Fundus photo; 2089x1764px: 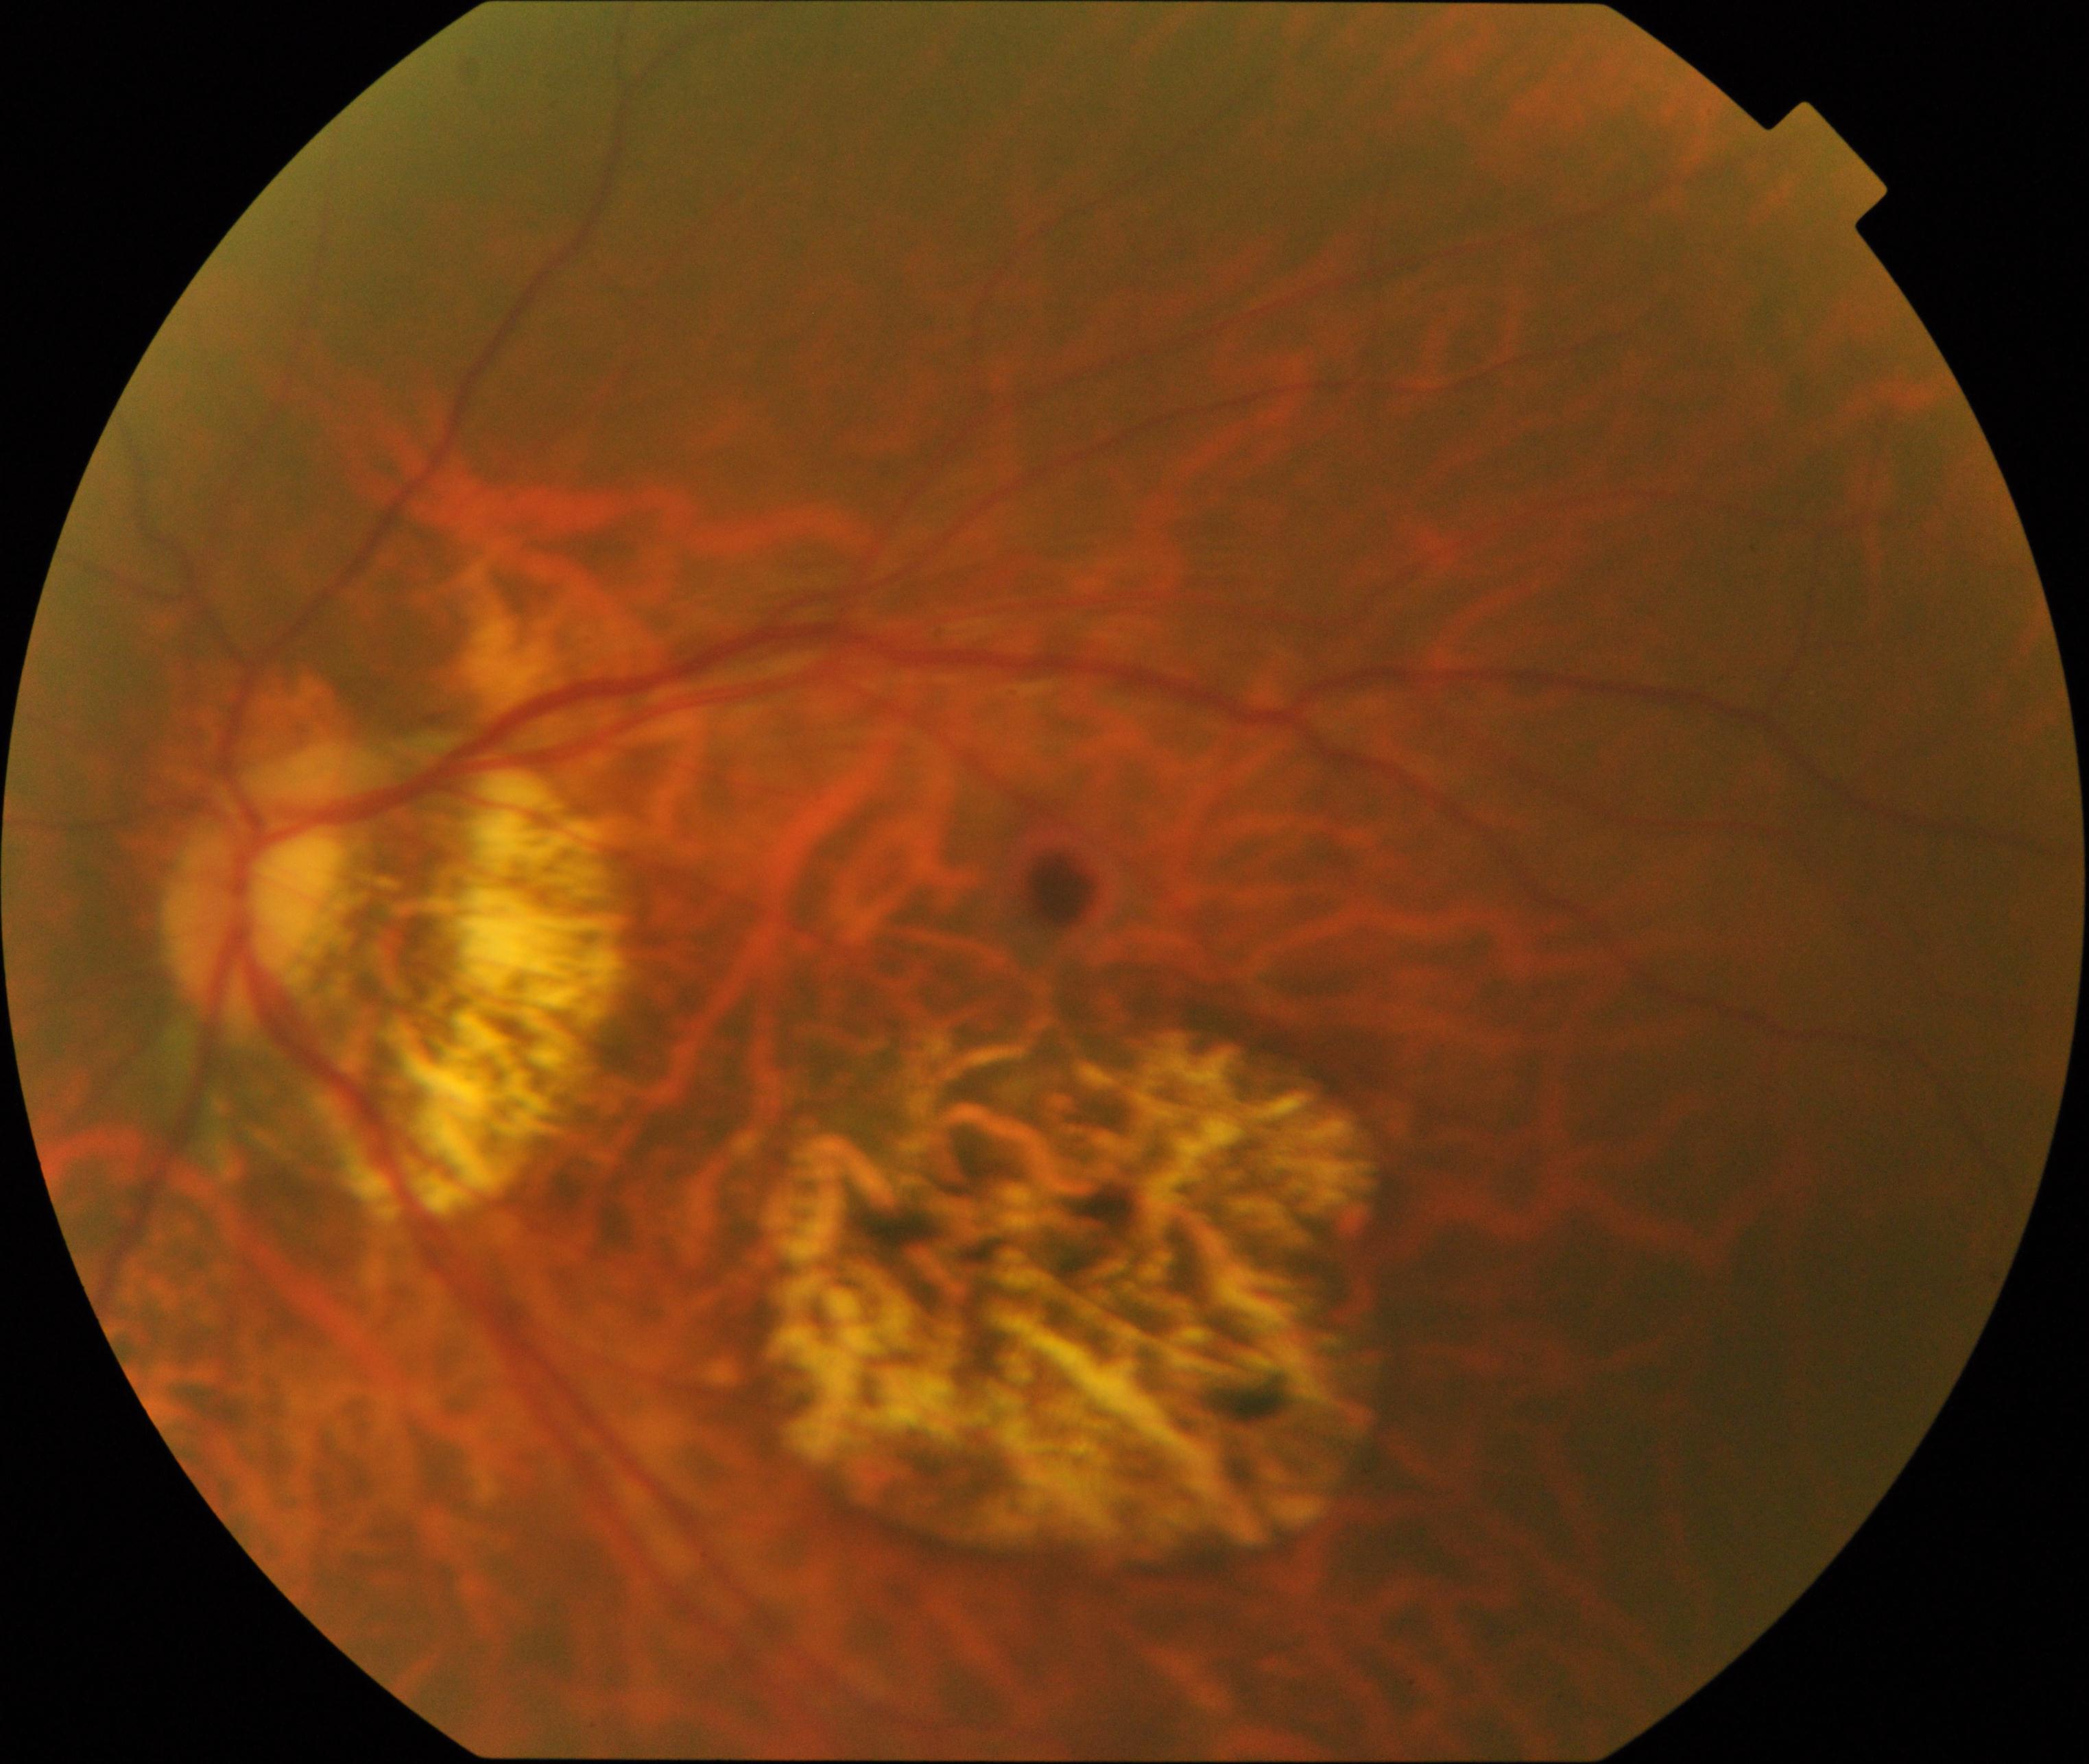
Demonstrates pathological myopia.